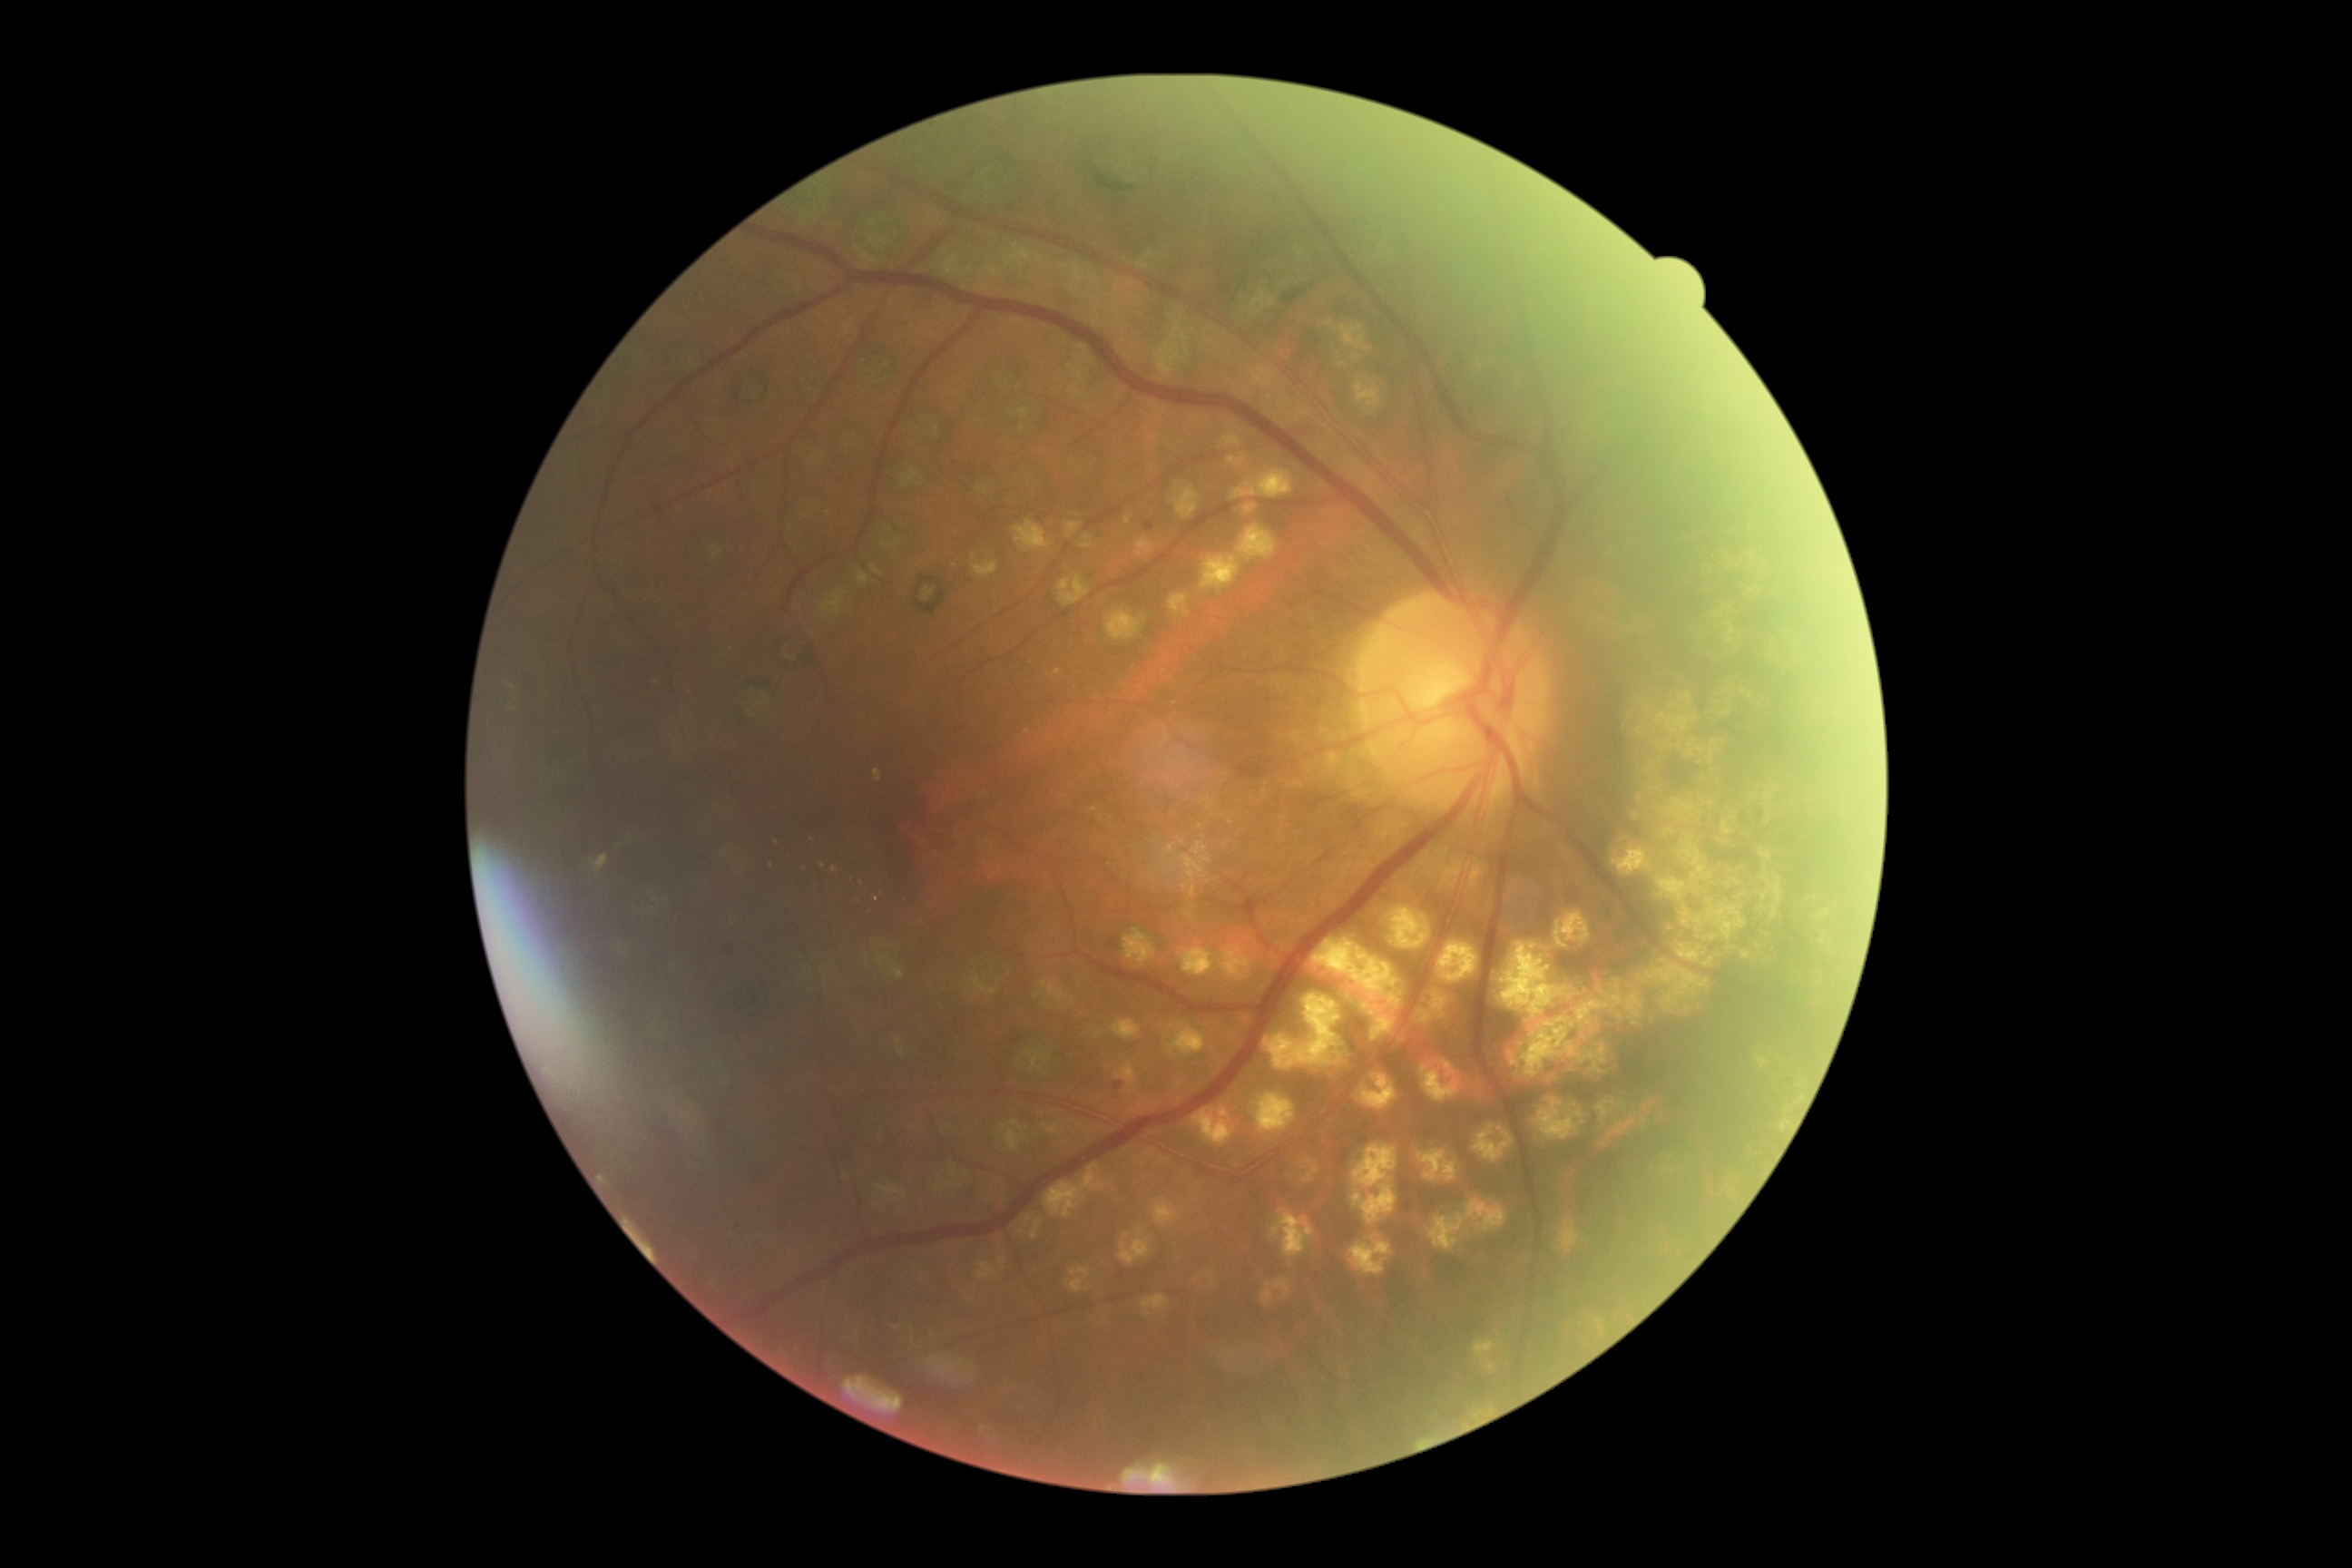

Diabetic retinopathy severity: grade 2 (moderate NPDR).